Modified Davis grading:
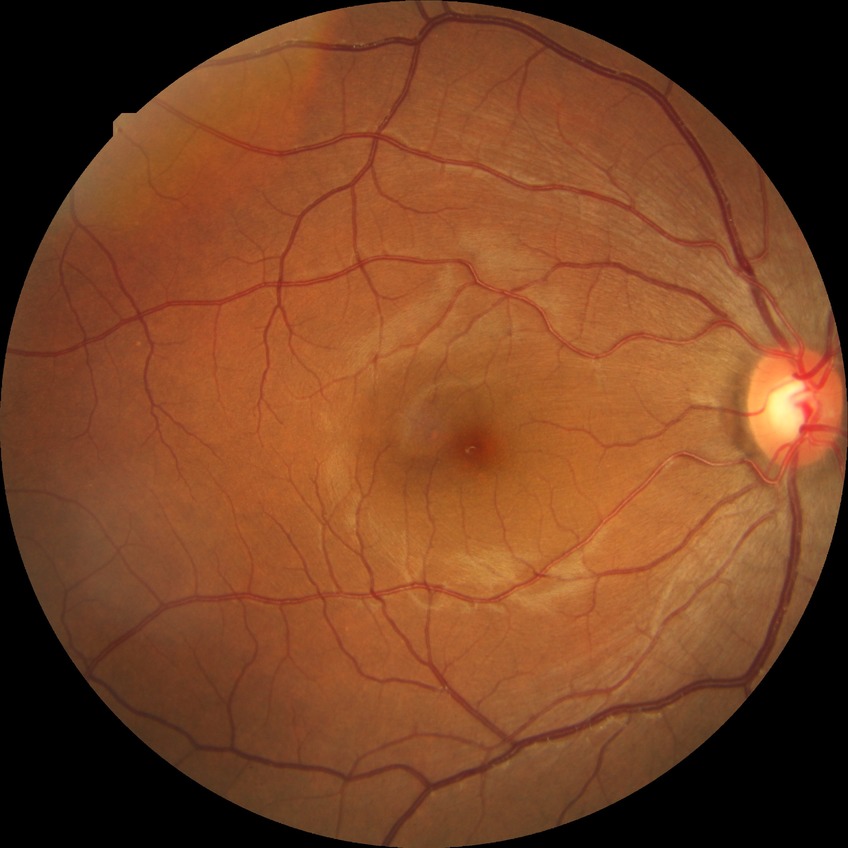
Annotations:
• retinopathy stage: no diabetic retinopathy